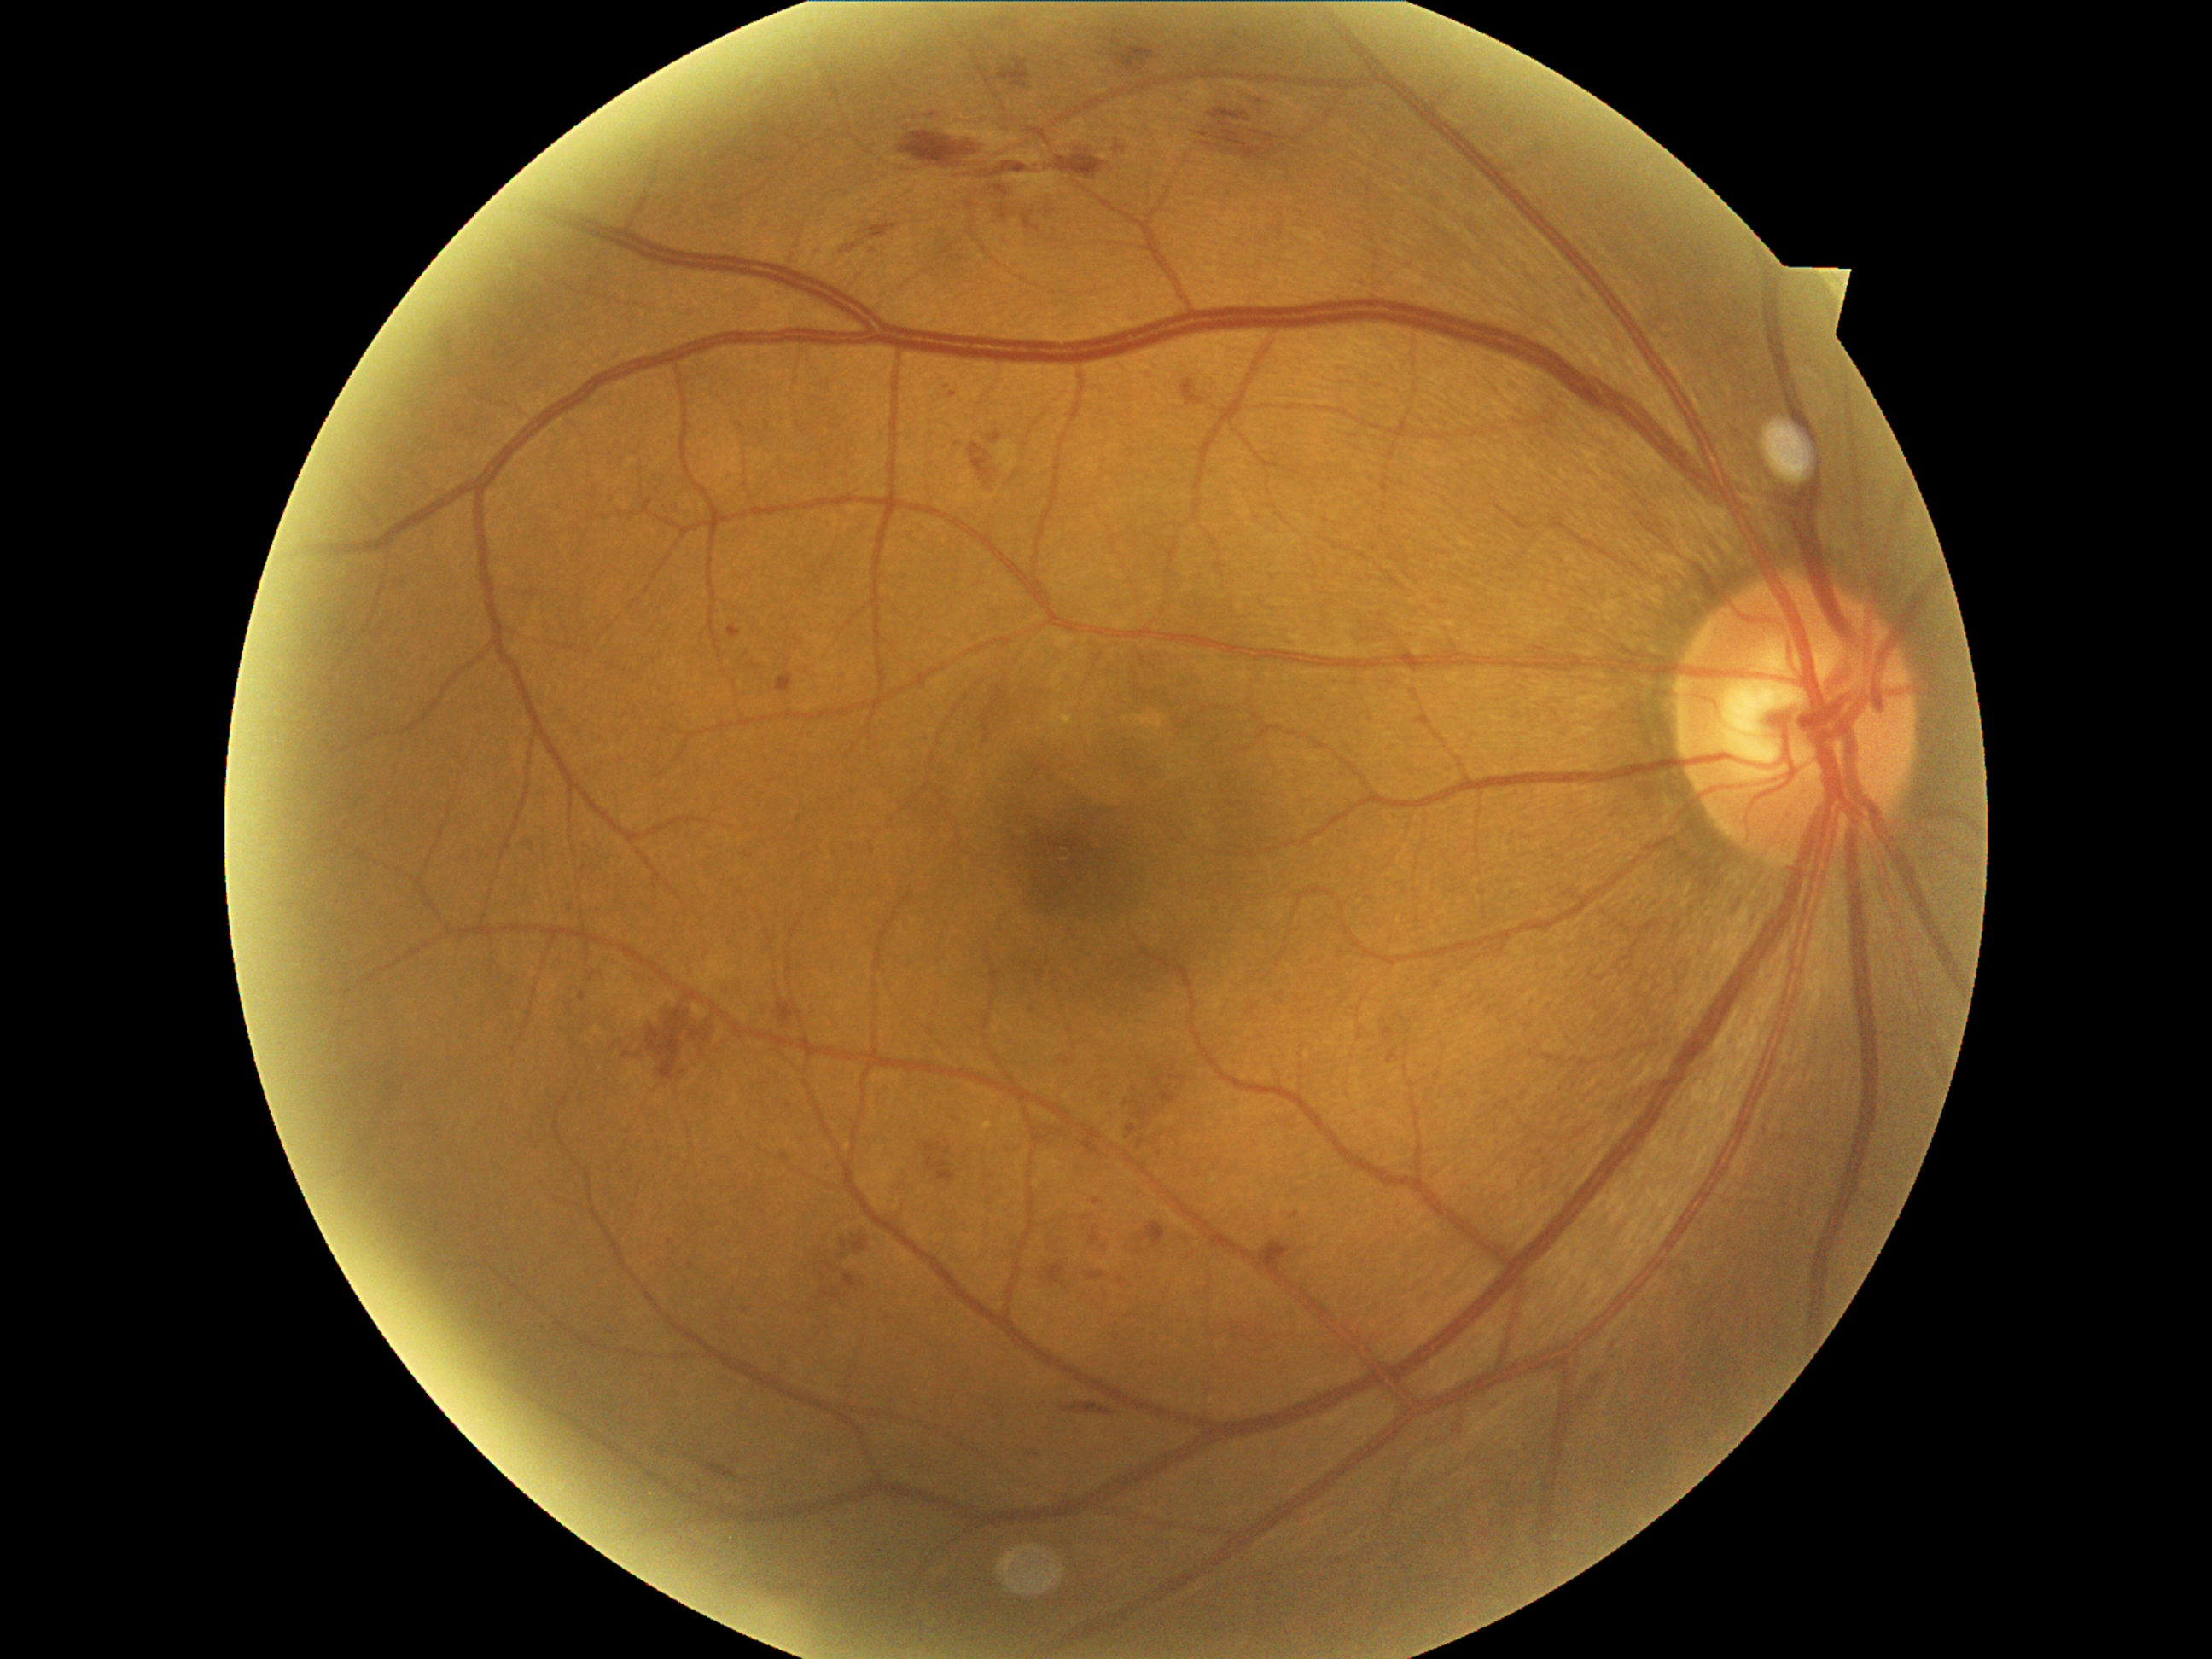
Diabetic retinopathy (DR) is grade 2 (moderate NPDR)
Selected lesions:
• hemorrhages (HEs) (more not shown): [1184,381,1204,405]; [1255,100,1264,105]; [989,434,1003,445]; [1416,714,1431,726]; [1209,107,1279,160]; [1040,1262,1066,1288]; [1139,1139,1146,1151]; [928,114,936,120]; [1170,1074,1189,1088]; [824,1262,839,1272]; [1025,211,1040,231]; [924,1143,957,1184]; [774,999,805,1030]; [1259,1240,1293,1272]; [776,672,795,694]
• HEs (small, approximate centers) near x=915 y=119; x=1136 y=1091; x=1123 y=1283